2352x1568, 45° FOV
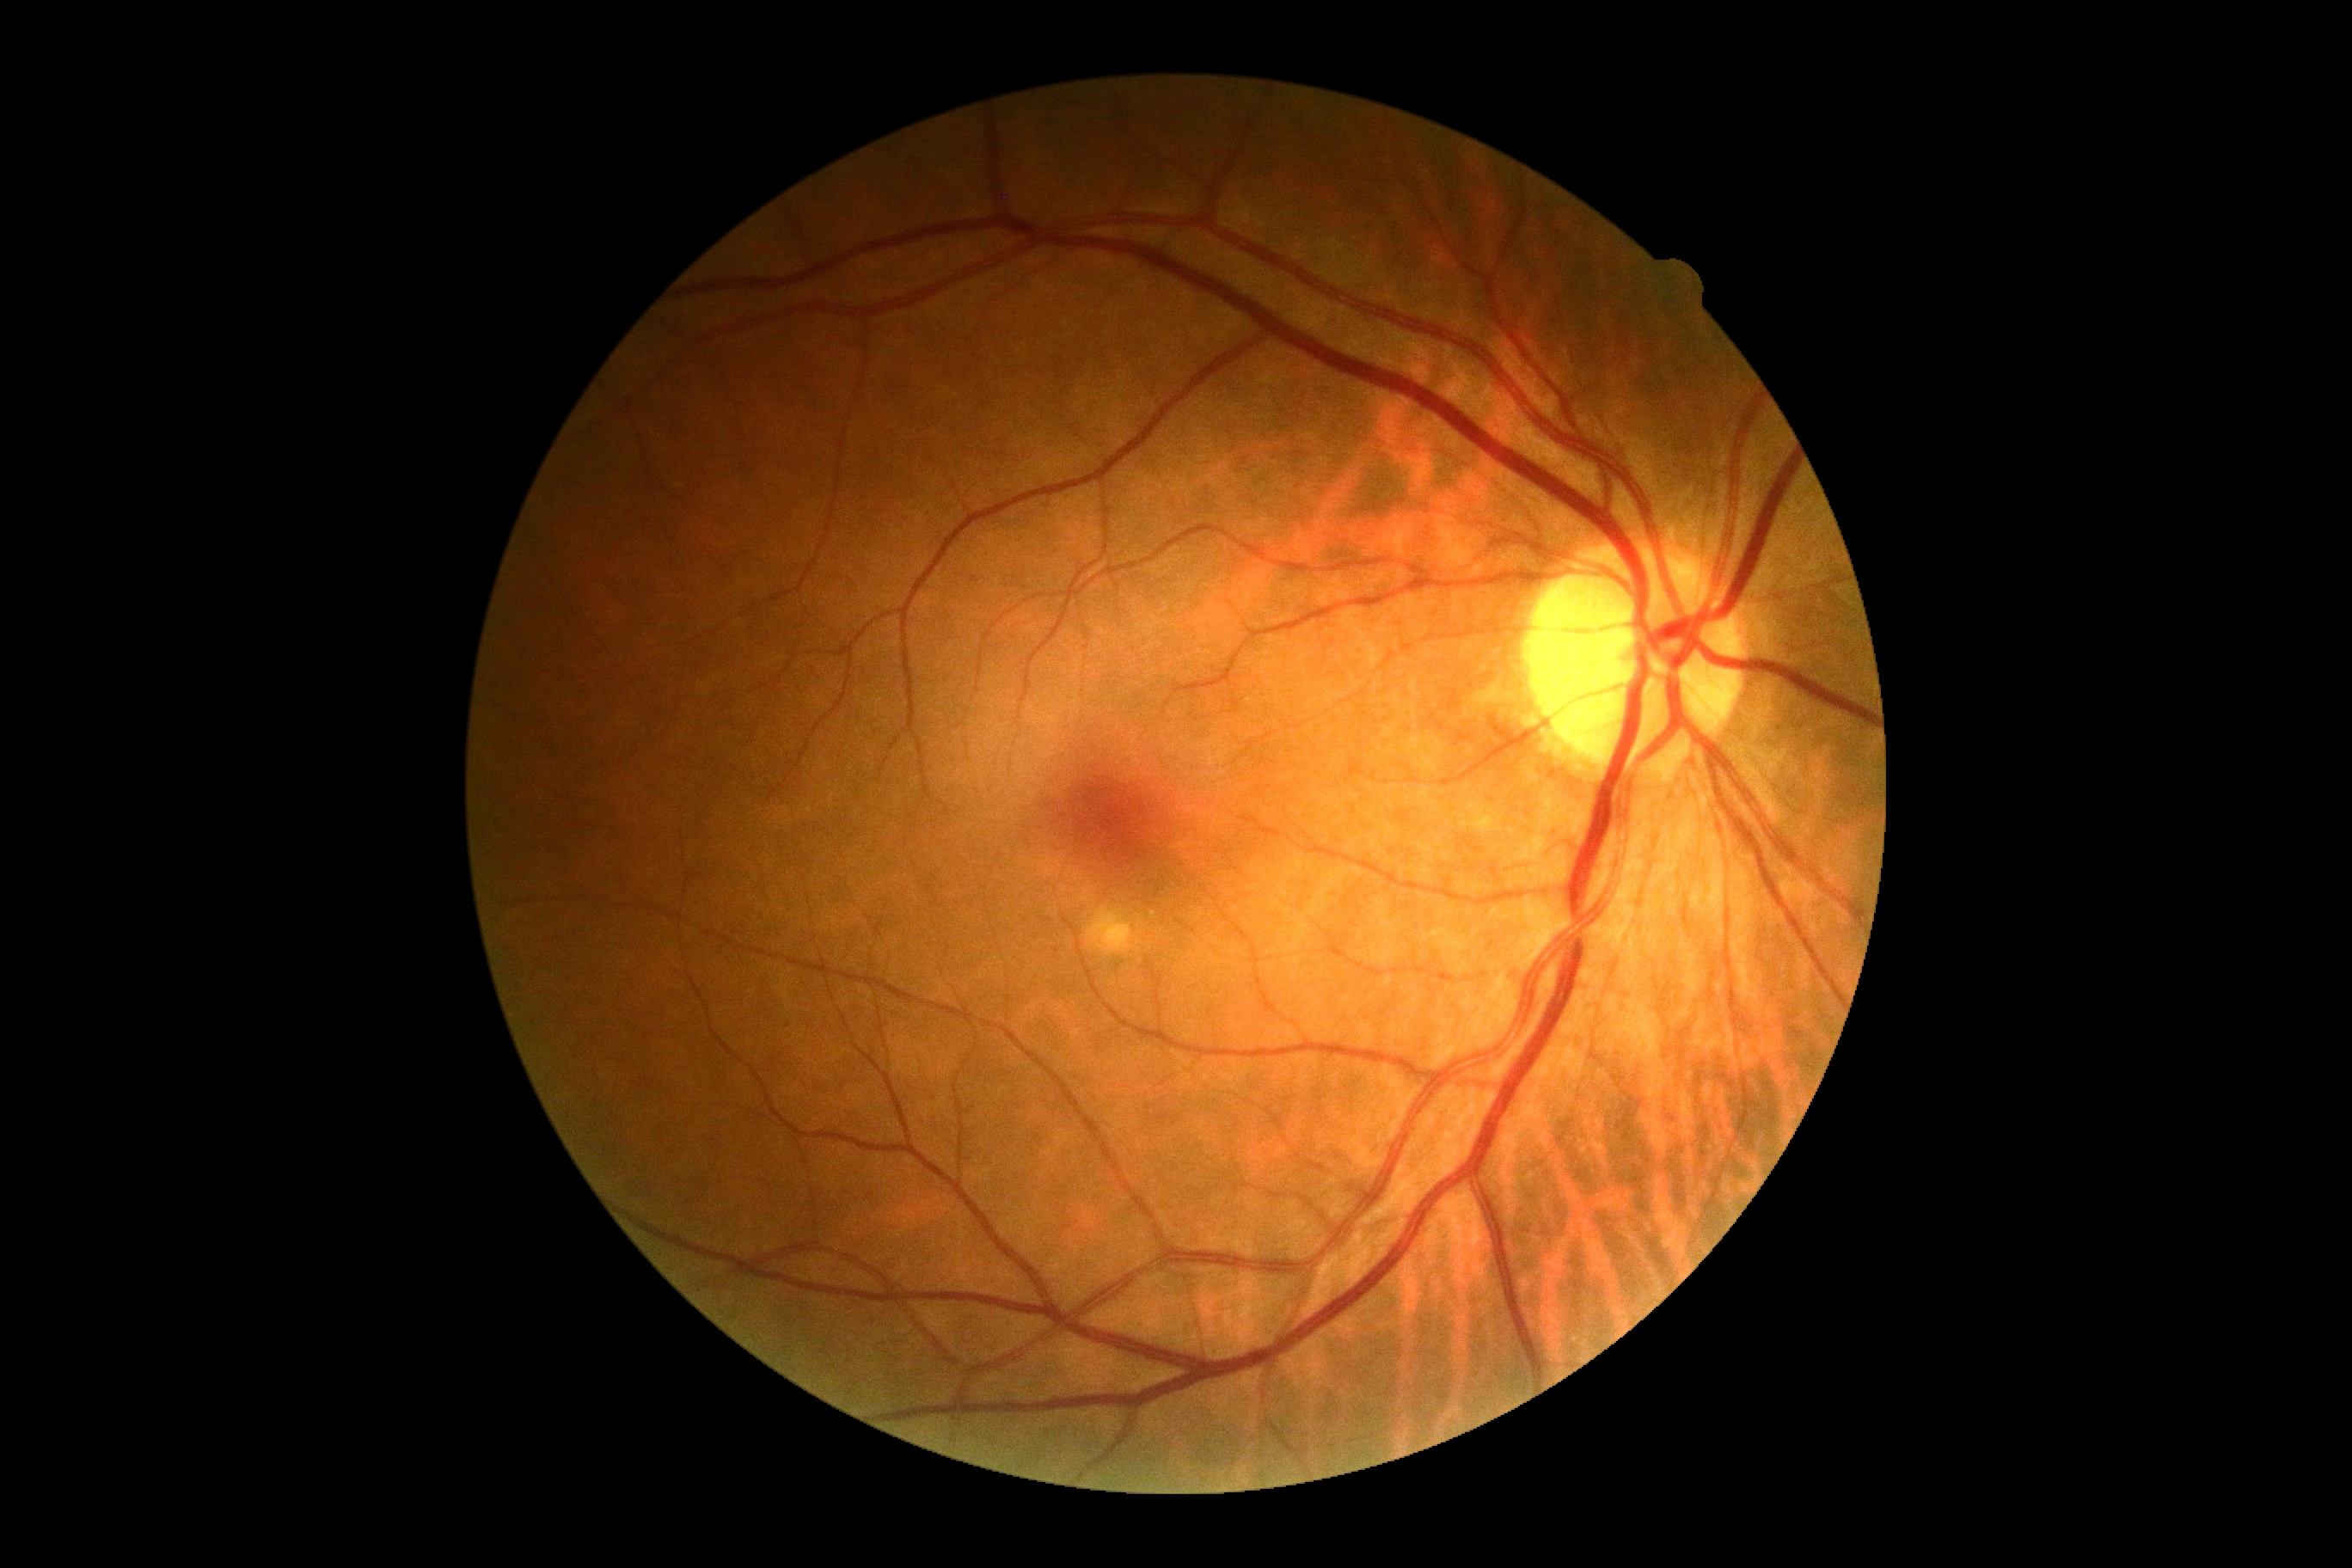

{
  "dr_grade": "grade 0"
}